Infant wide-field retinal image
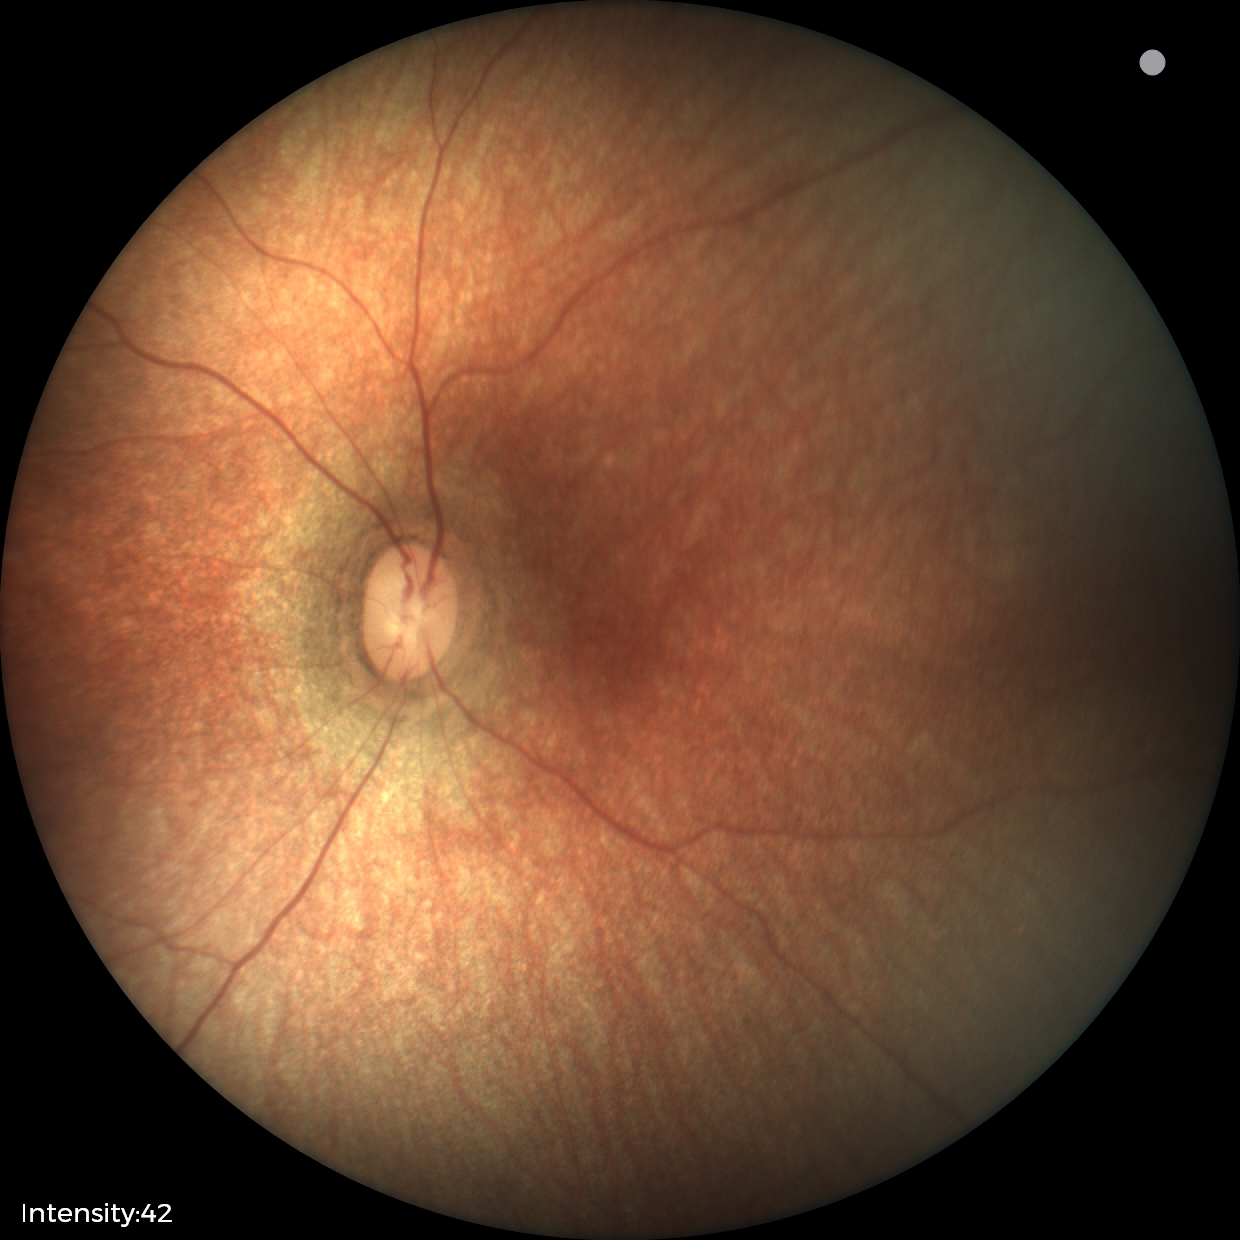

Q: What is the diagnosis from this examination?
A: physiological appearance with no retinal pathology